2212x1659px; CFP — 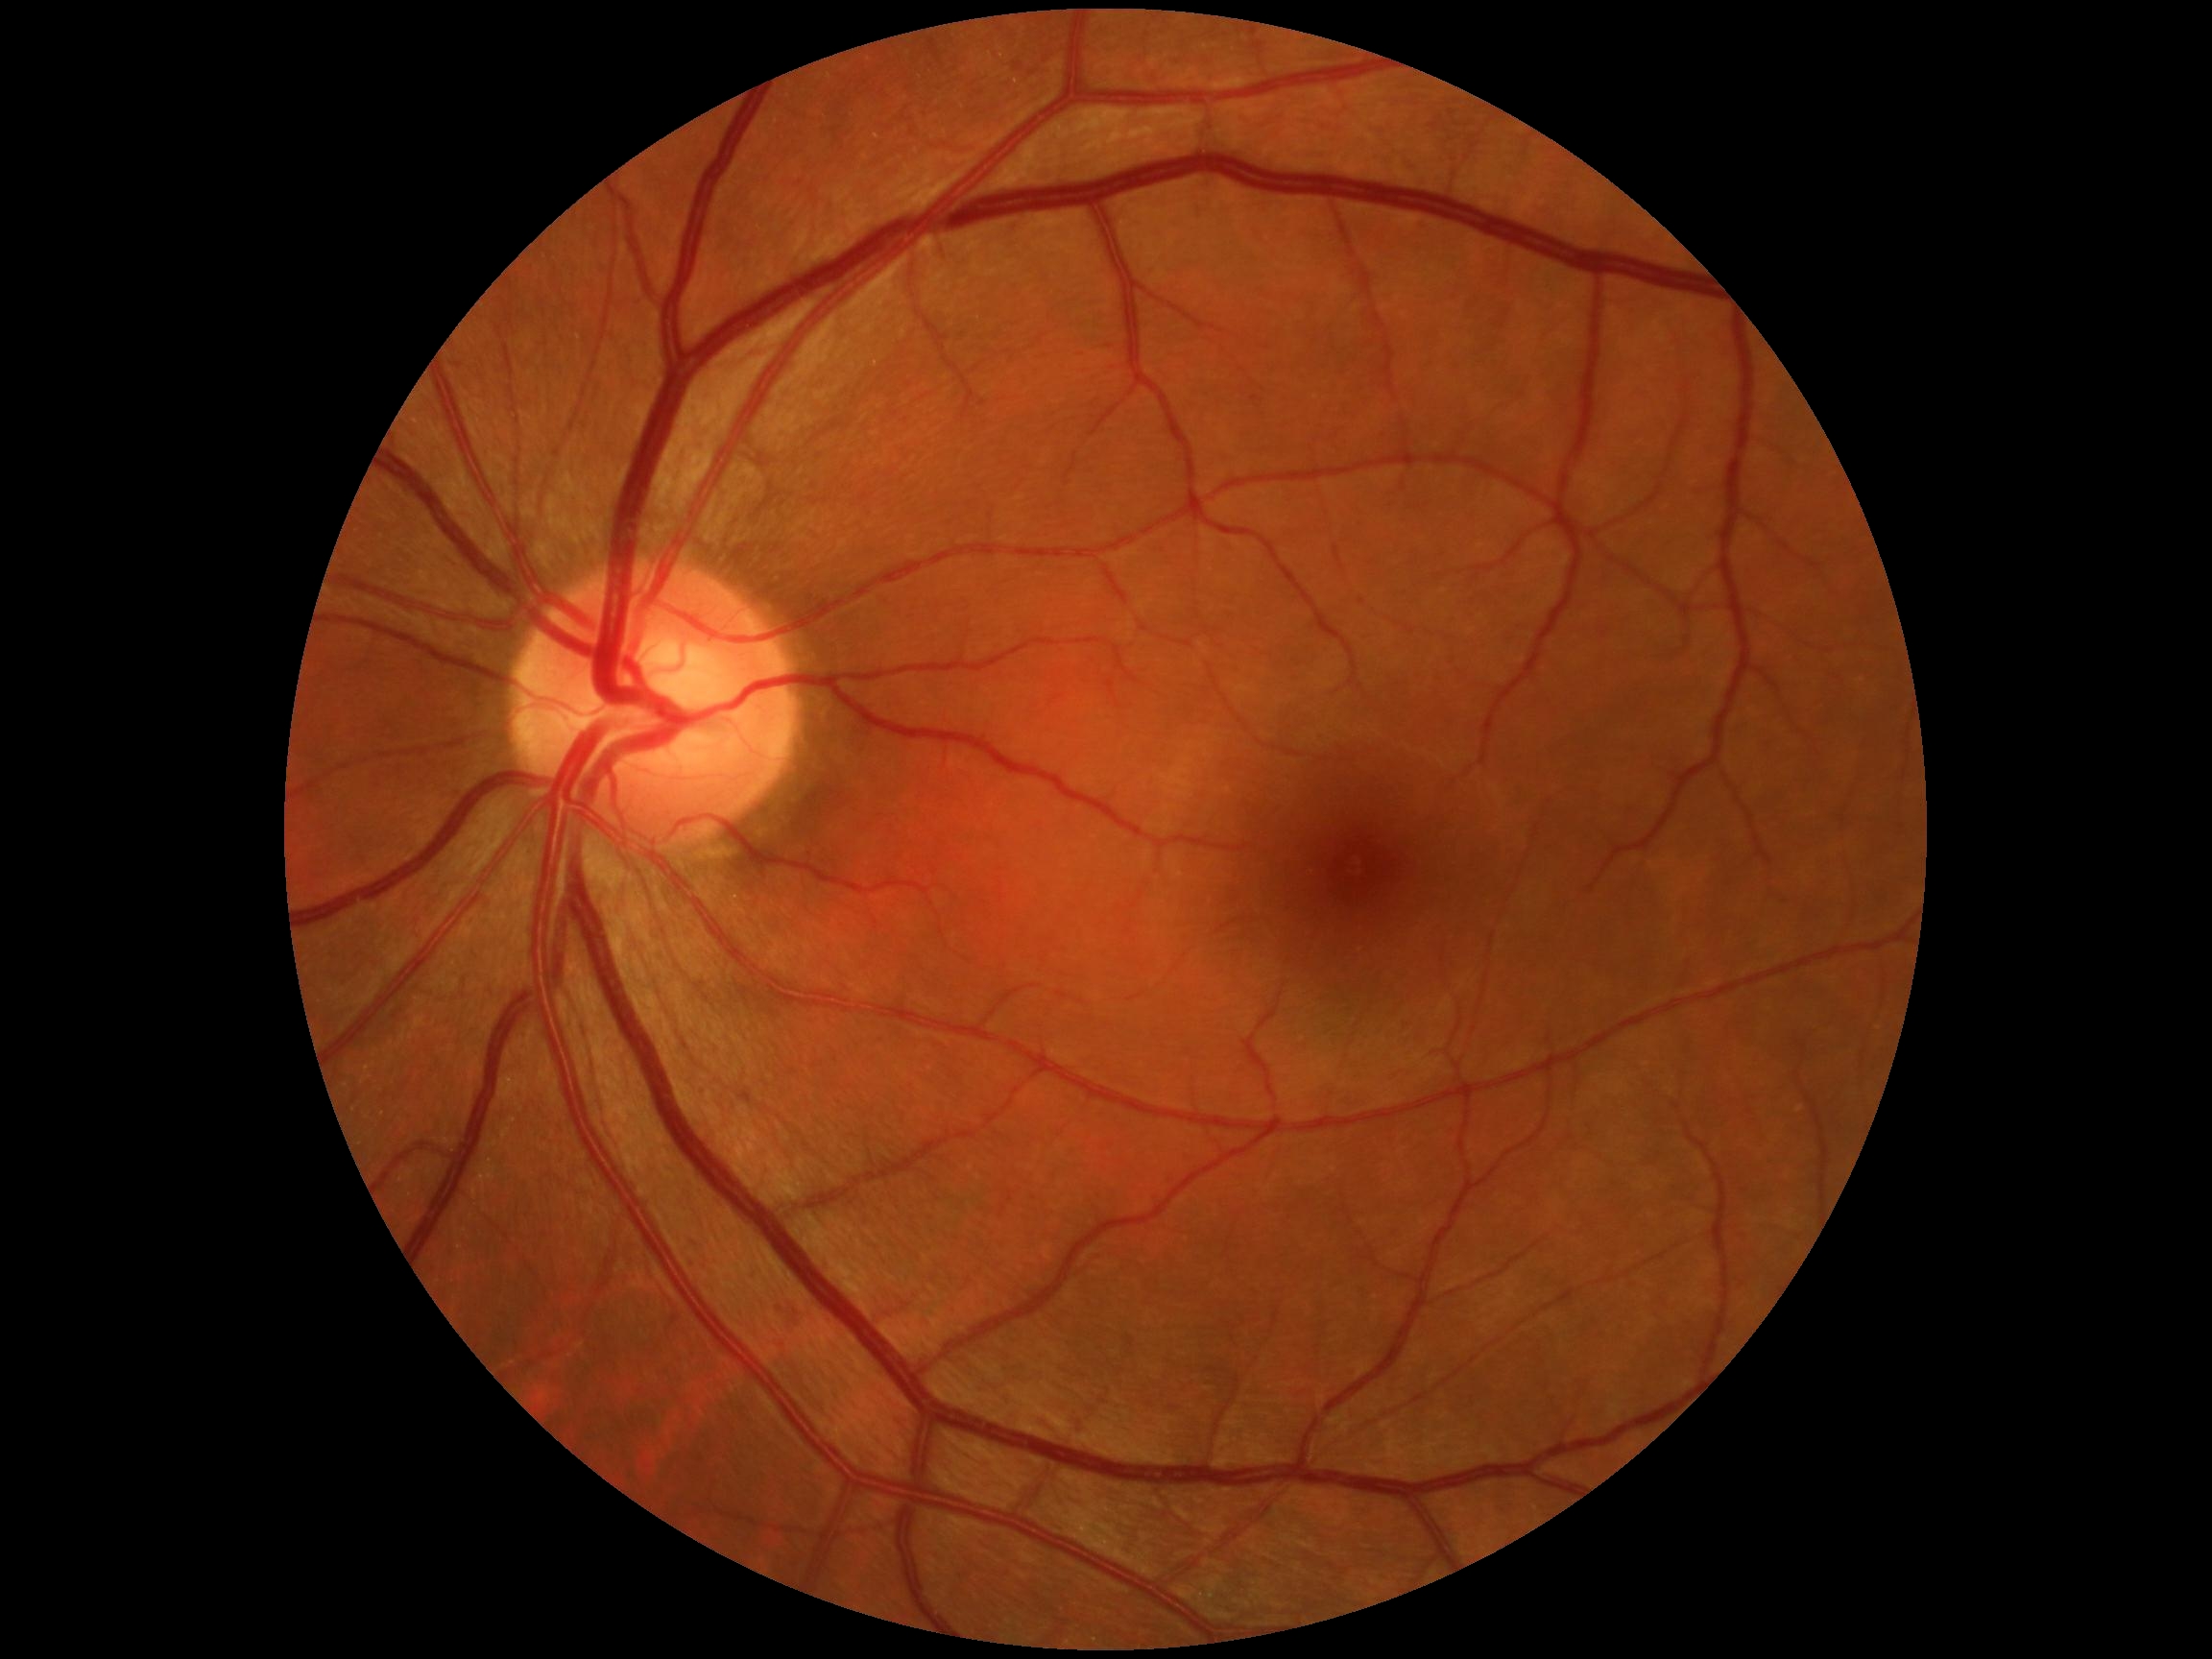
DR grade: 0/4 — no visible signs of diabetic retinopathy.